DR severity per modified Davis staging, CFP, nonmydriatic fundus photograph
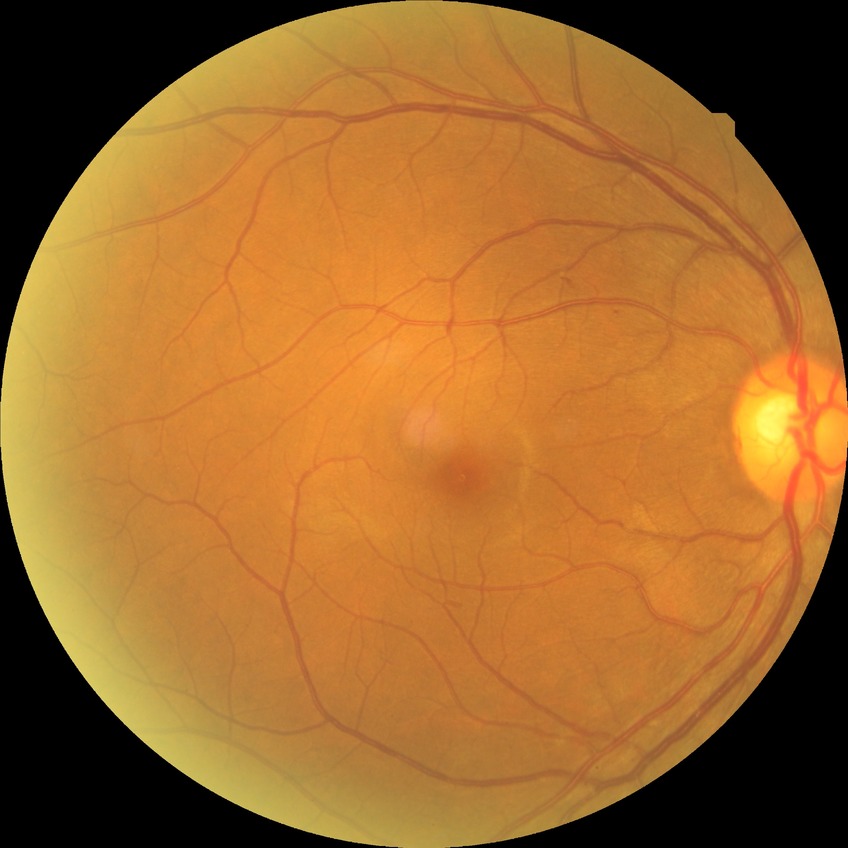 Diabetic retinopathy (DR) is simple diabetic retinopathy (SDR).